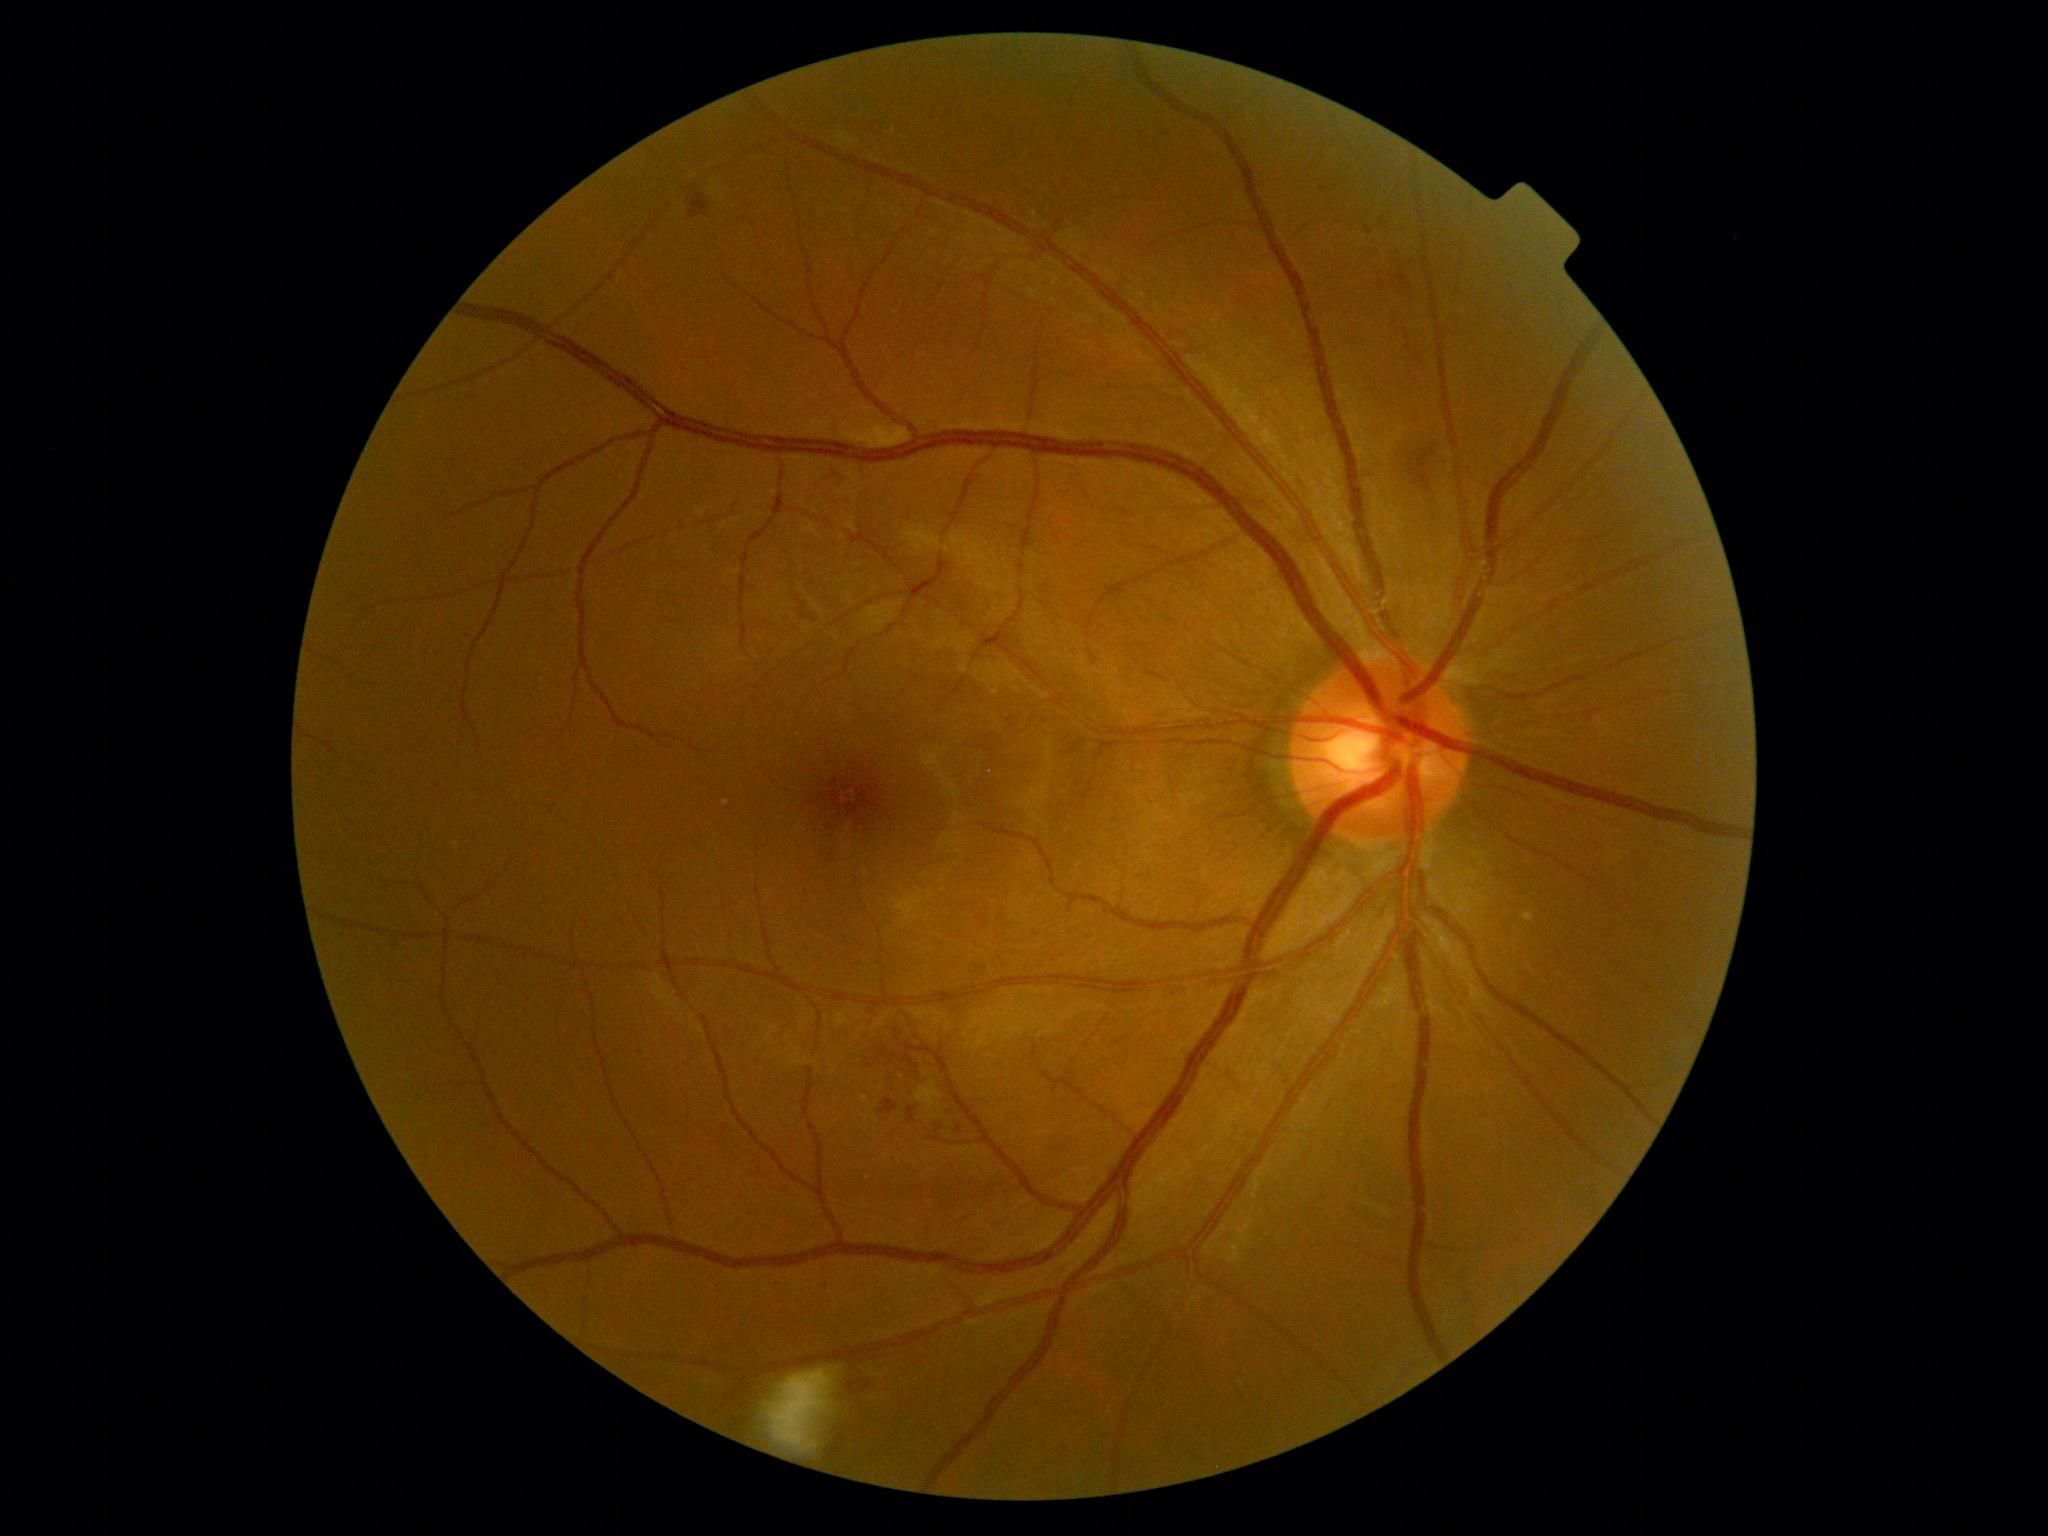
DR stage is grade 2.